Diabetic retinopathy graded by the modified Davis classification — 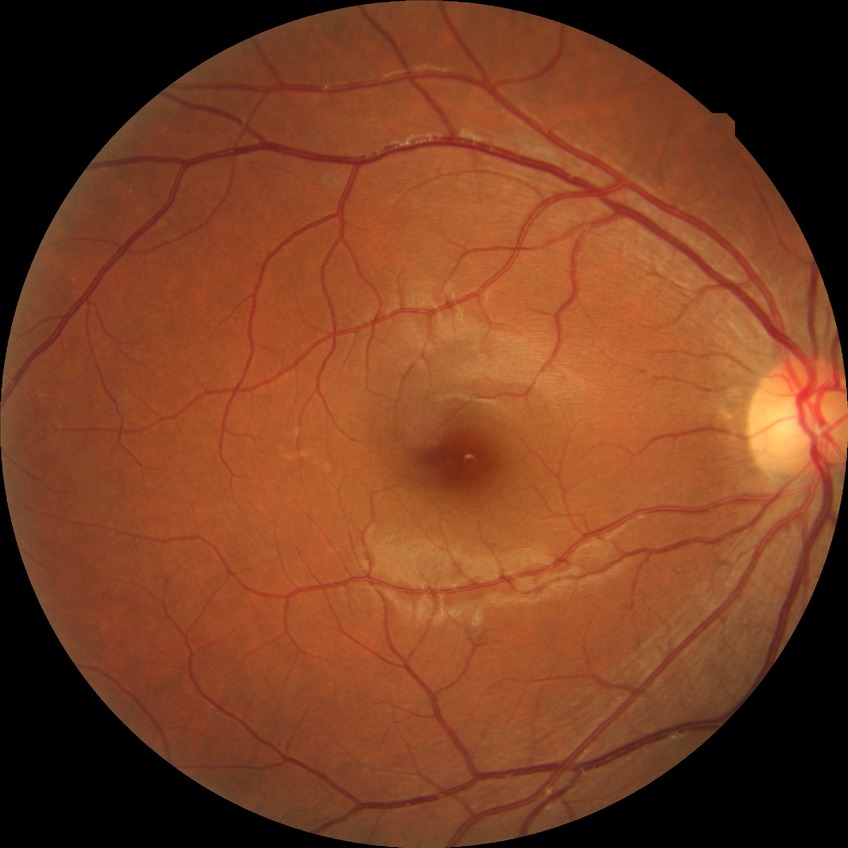

– diabetic retinopathy (DR) — no diabetic retinopathy (NDR)